Color fundus image
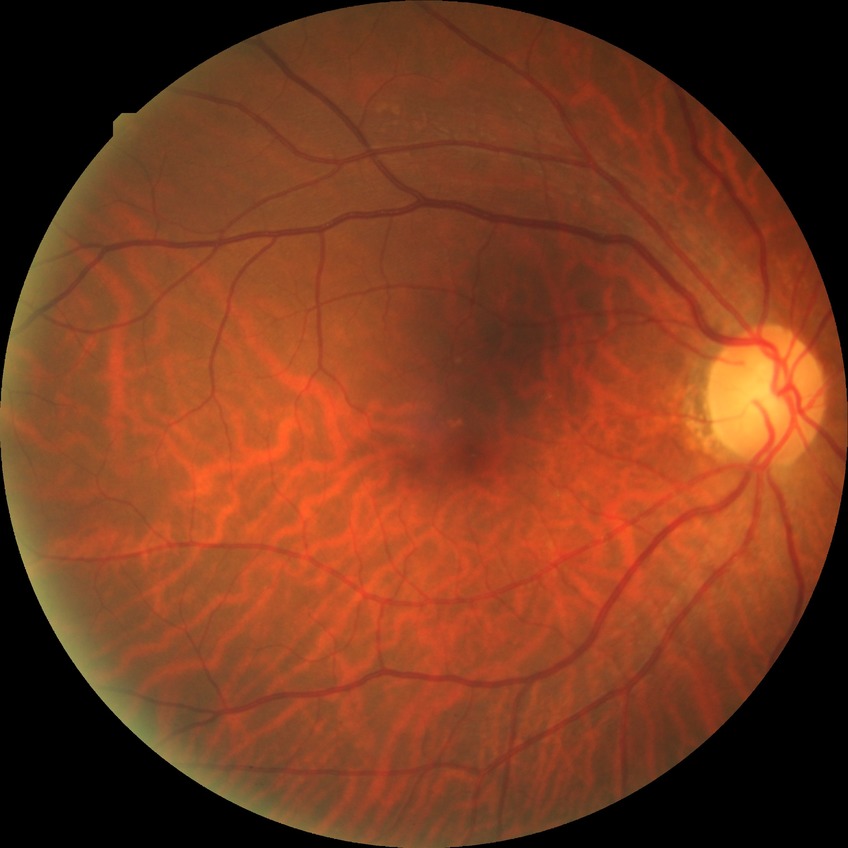
Diabetic retinopathy grade: no diabetic retinopathy.